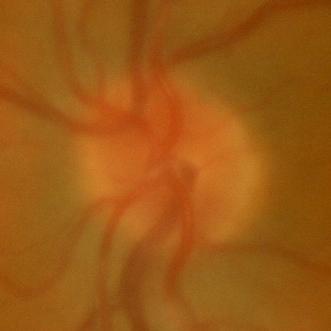
ONH-centered fundus image showing no signs of glaucoma.